45 degree fundus photograph; NIDEK AFC-230 fundus camera; 848 x 848 pixels; nonmydriatic fundus photograph; posterior pole color fundus photograph; modified Davis grading
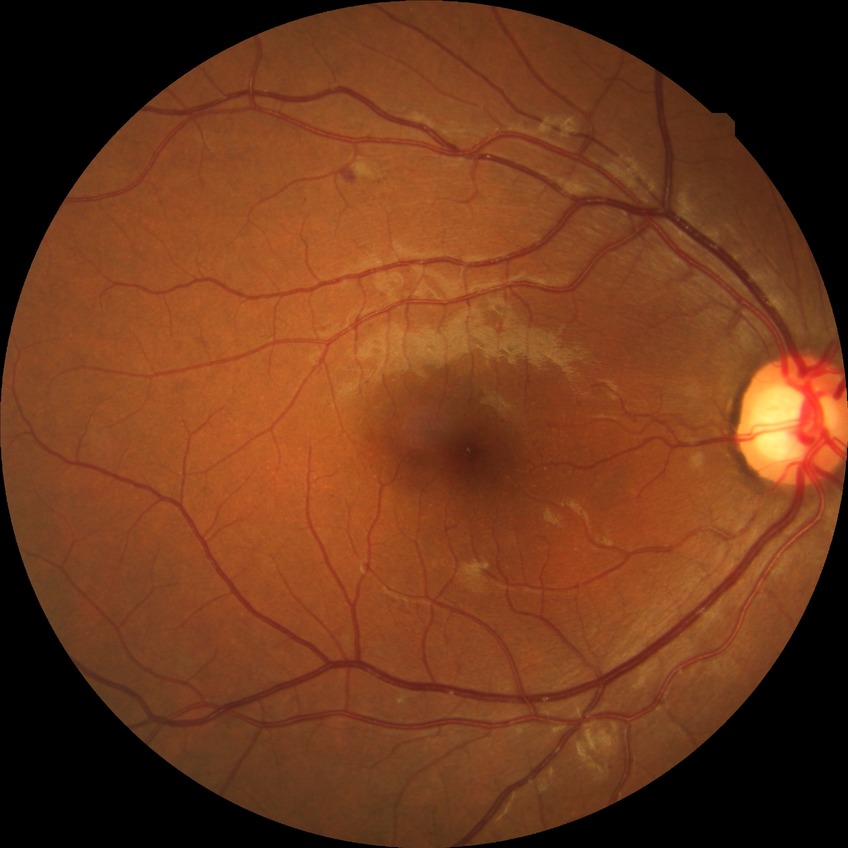

Diabetic retinopathy stage: pre-proliferative diabetic retinopathy.